FOV: 50 degrees; tabletop color fundus camera image.
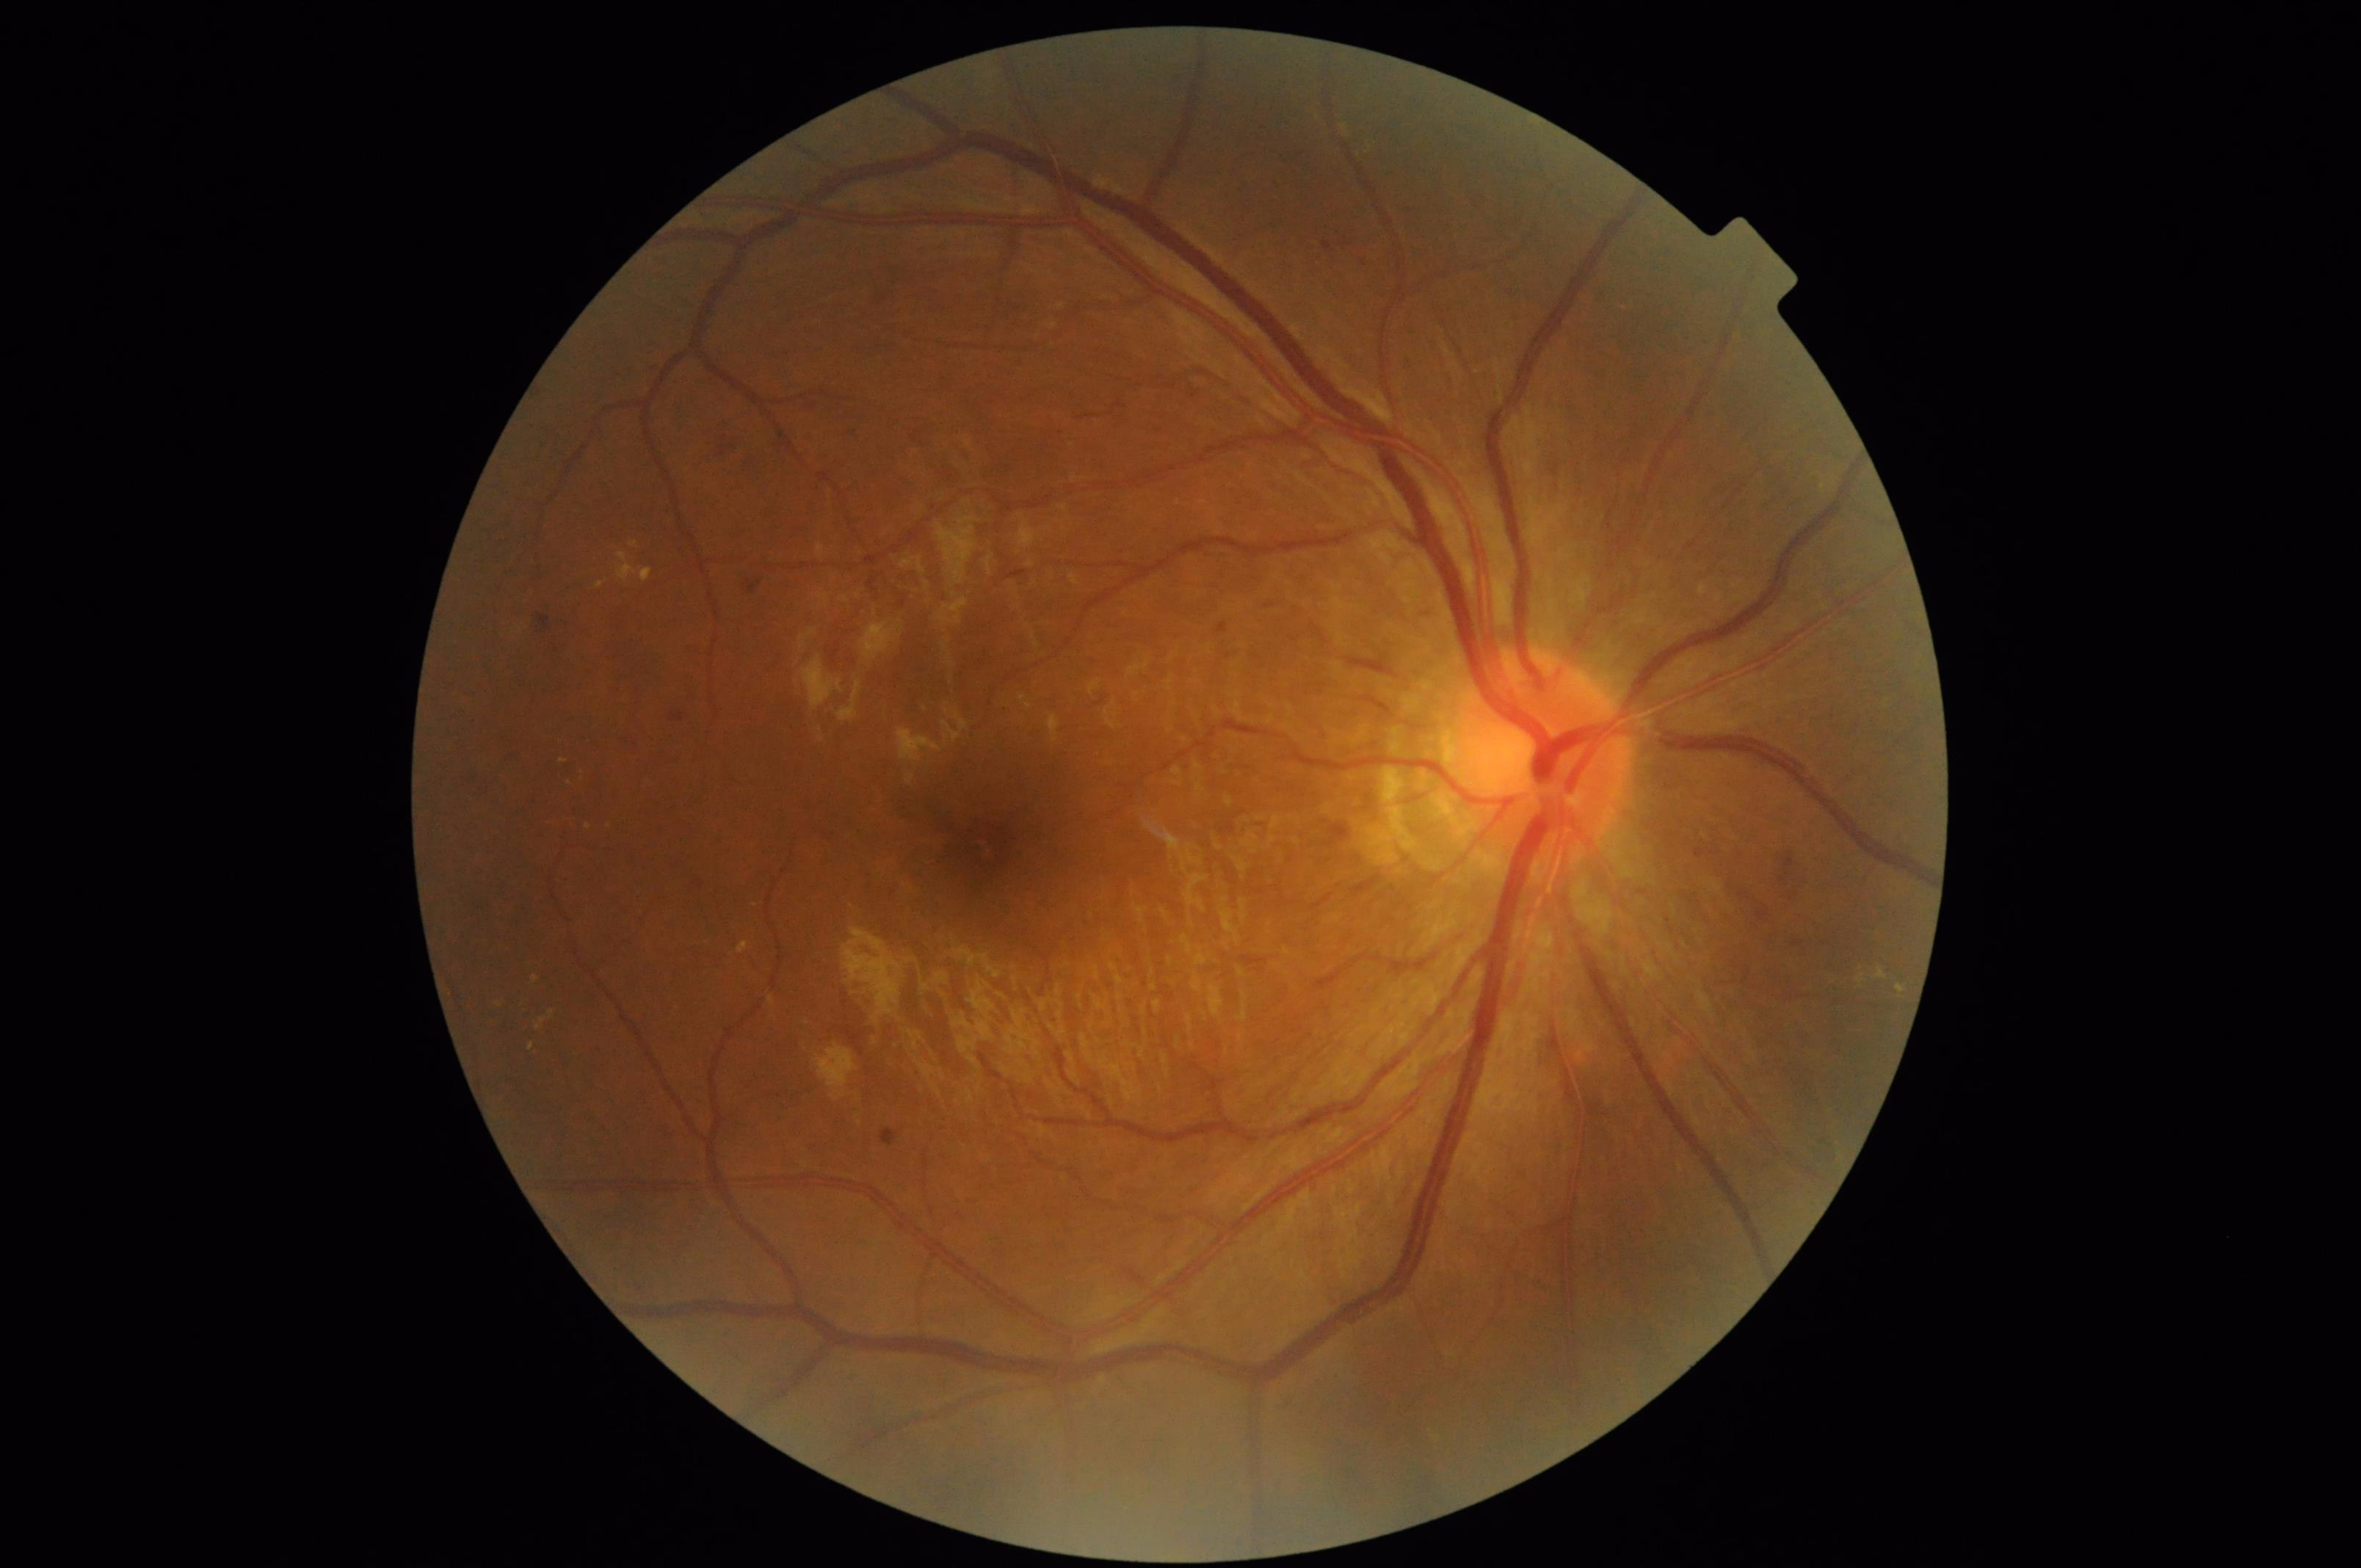

No over- or under-exposure.
Overall quality is good and the image is gradable.
Optic disc, vessels, and background are in focus.